Camera: Remidio FOP fundus camera:
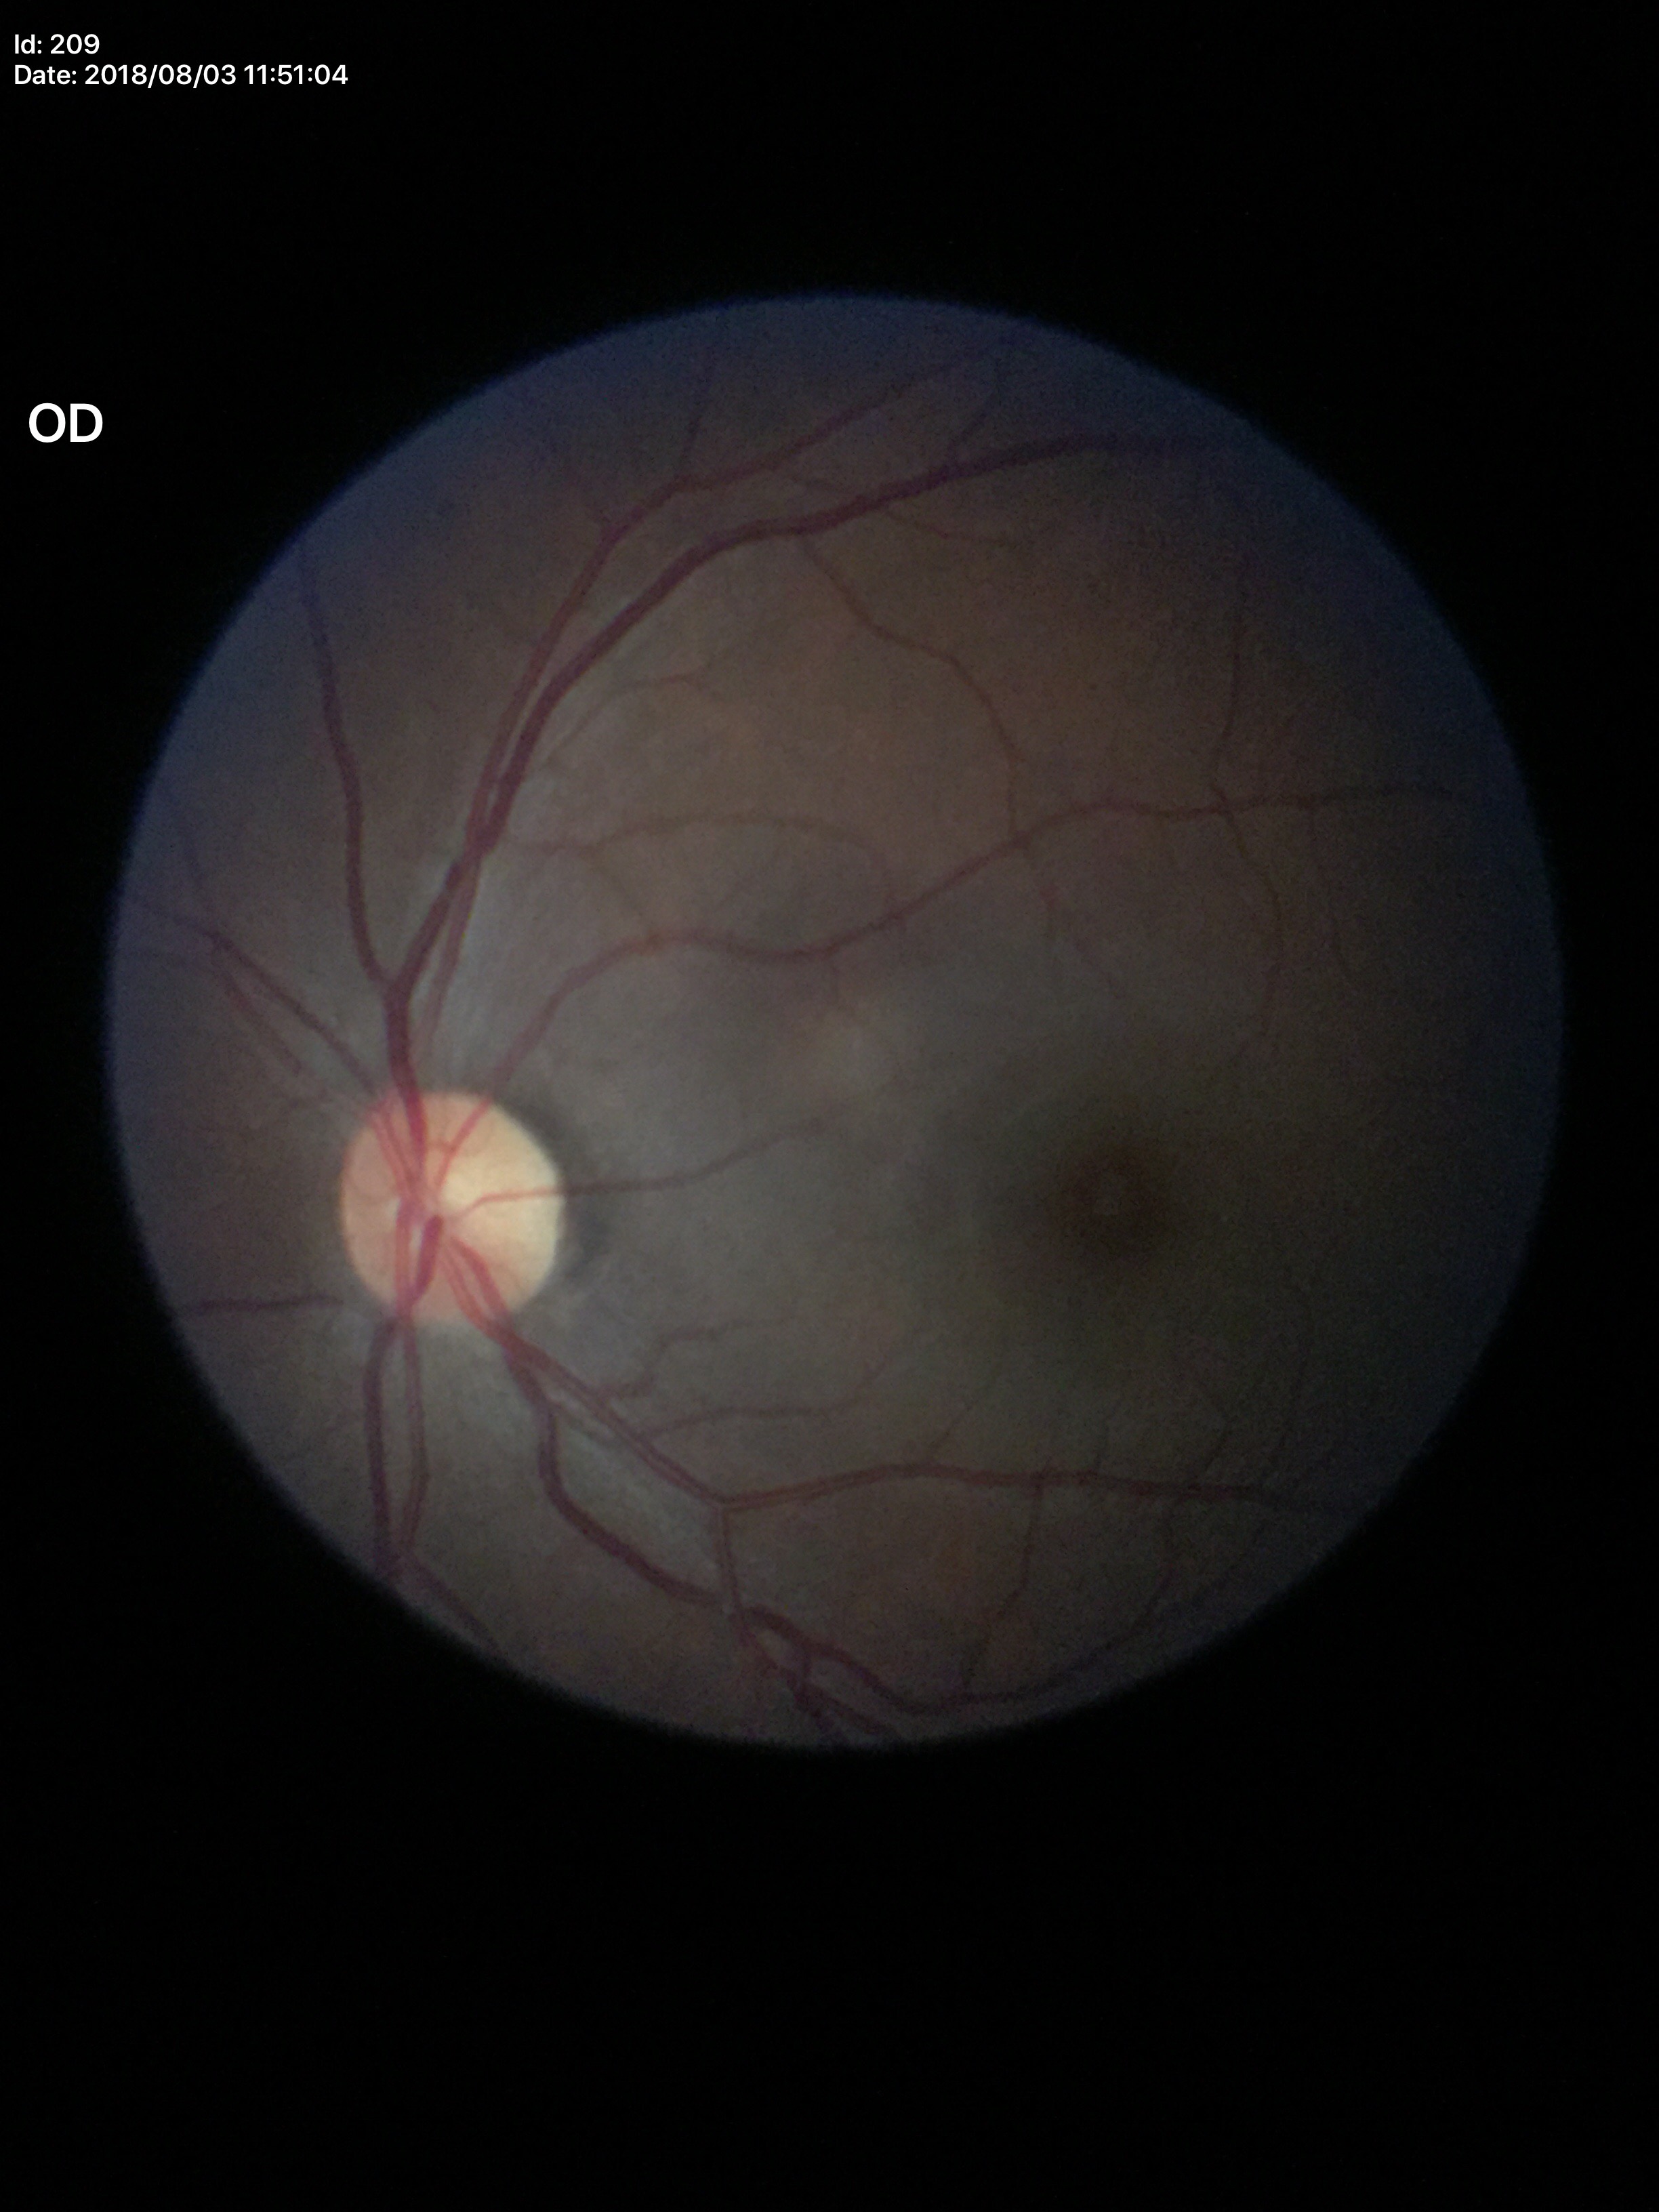 No signs of glaucoma. Vertical CDR is 0.46.